Wide-field fundus photograph from neonatal ROP screening. Camera: Phoenix ICON (100° FOV) — 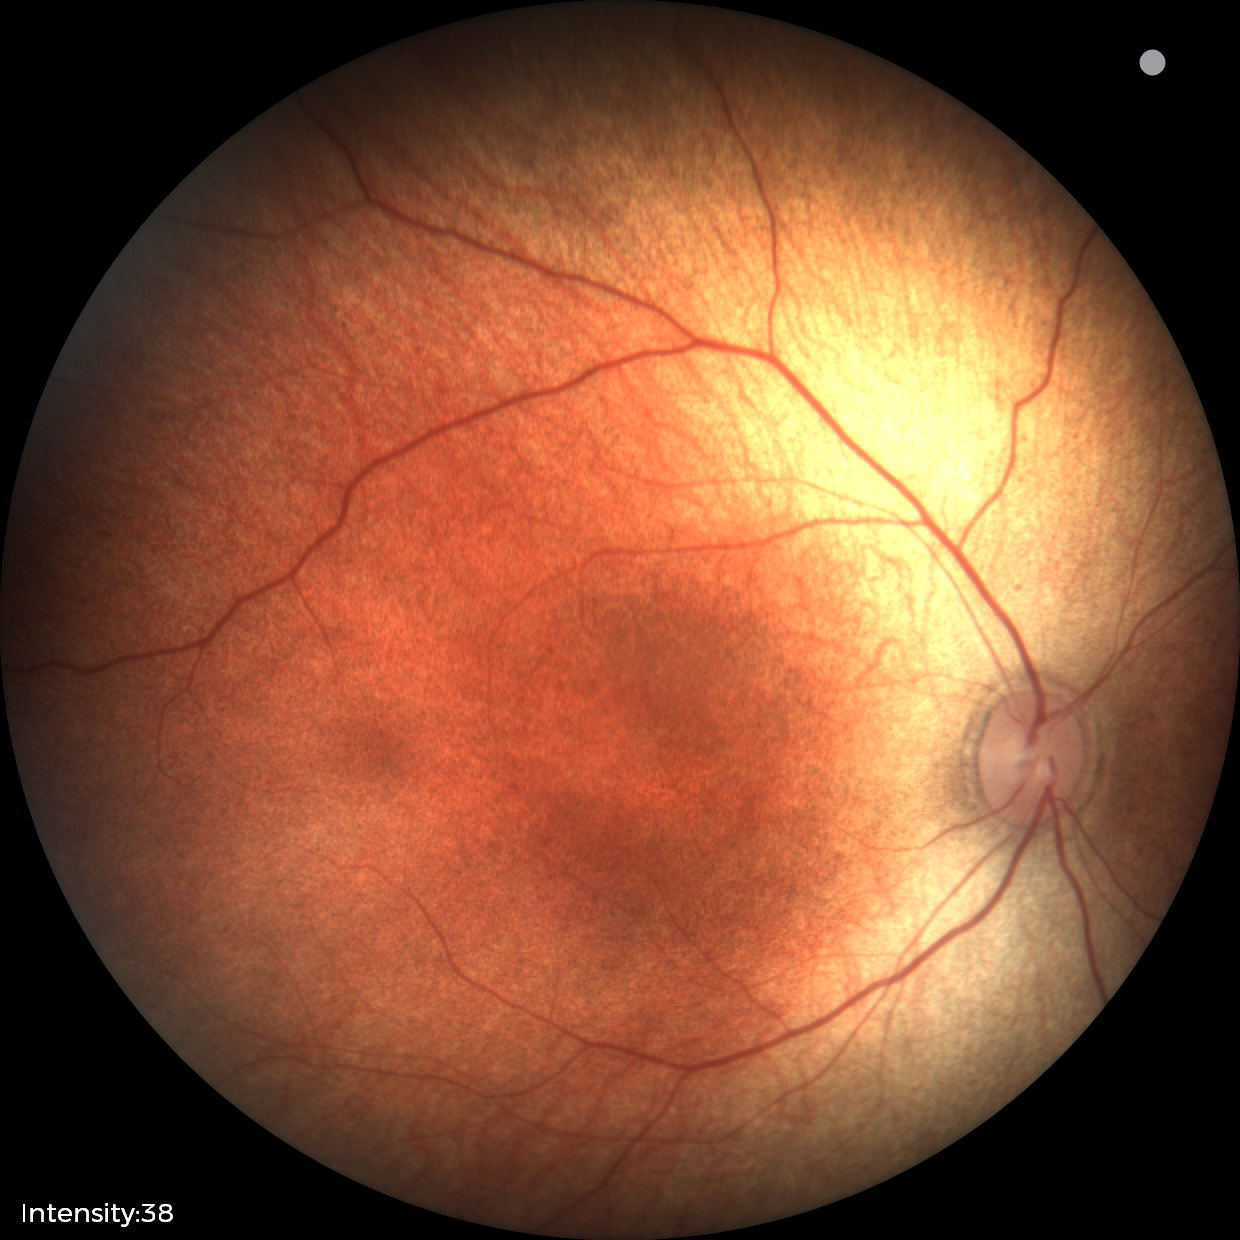 Screening: normal fundus examination.